Without pupil dilation: 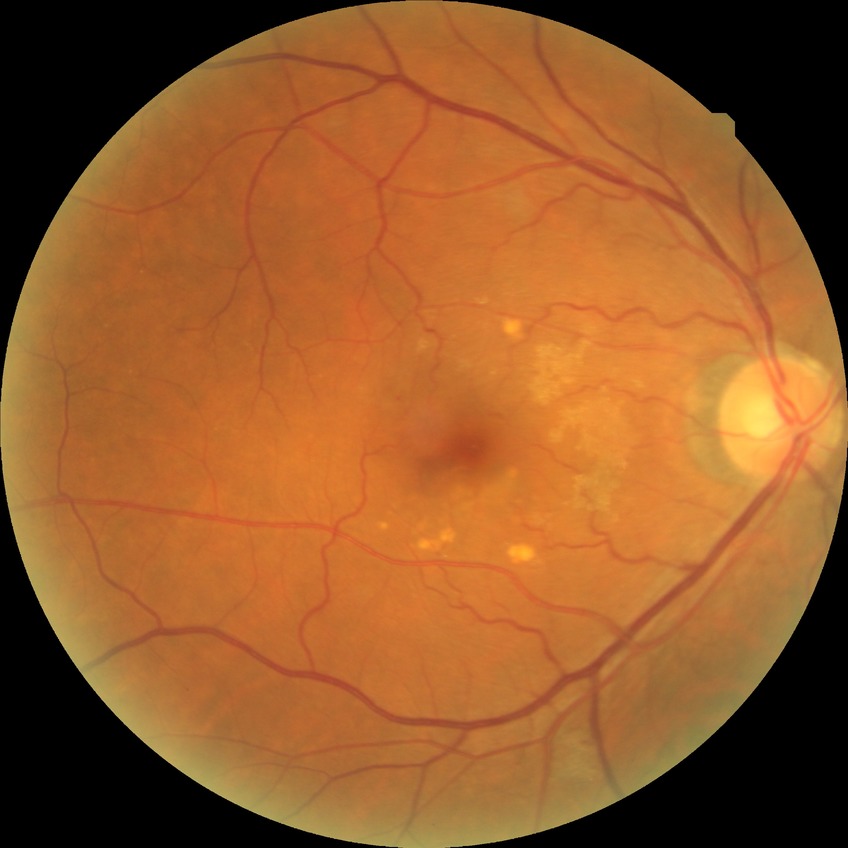

diabetic retinopathy (DR): no diabetic retinopathy (NDR).